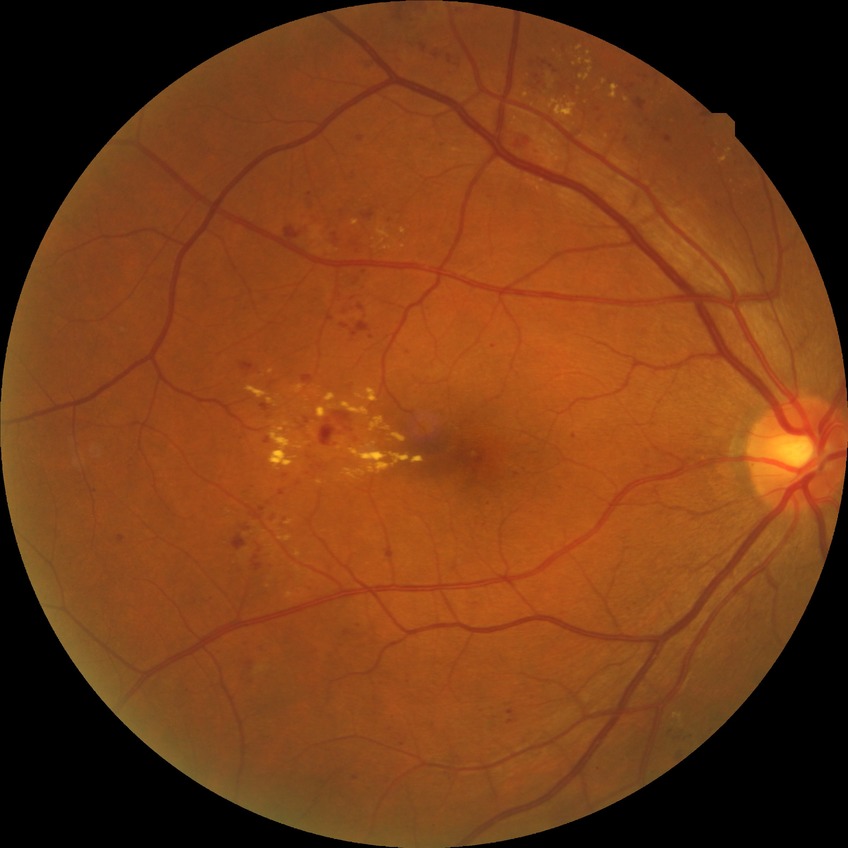

Modified Davis grade: SDR.